UWF retinal mosaic · FOV: 200 degrees.
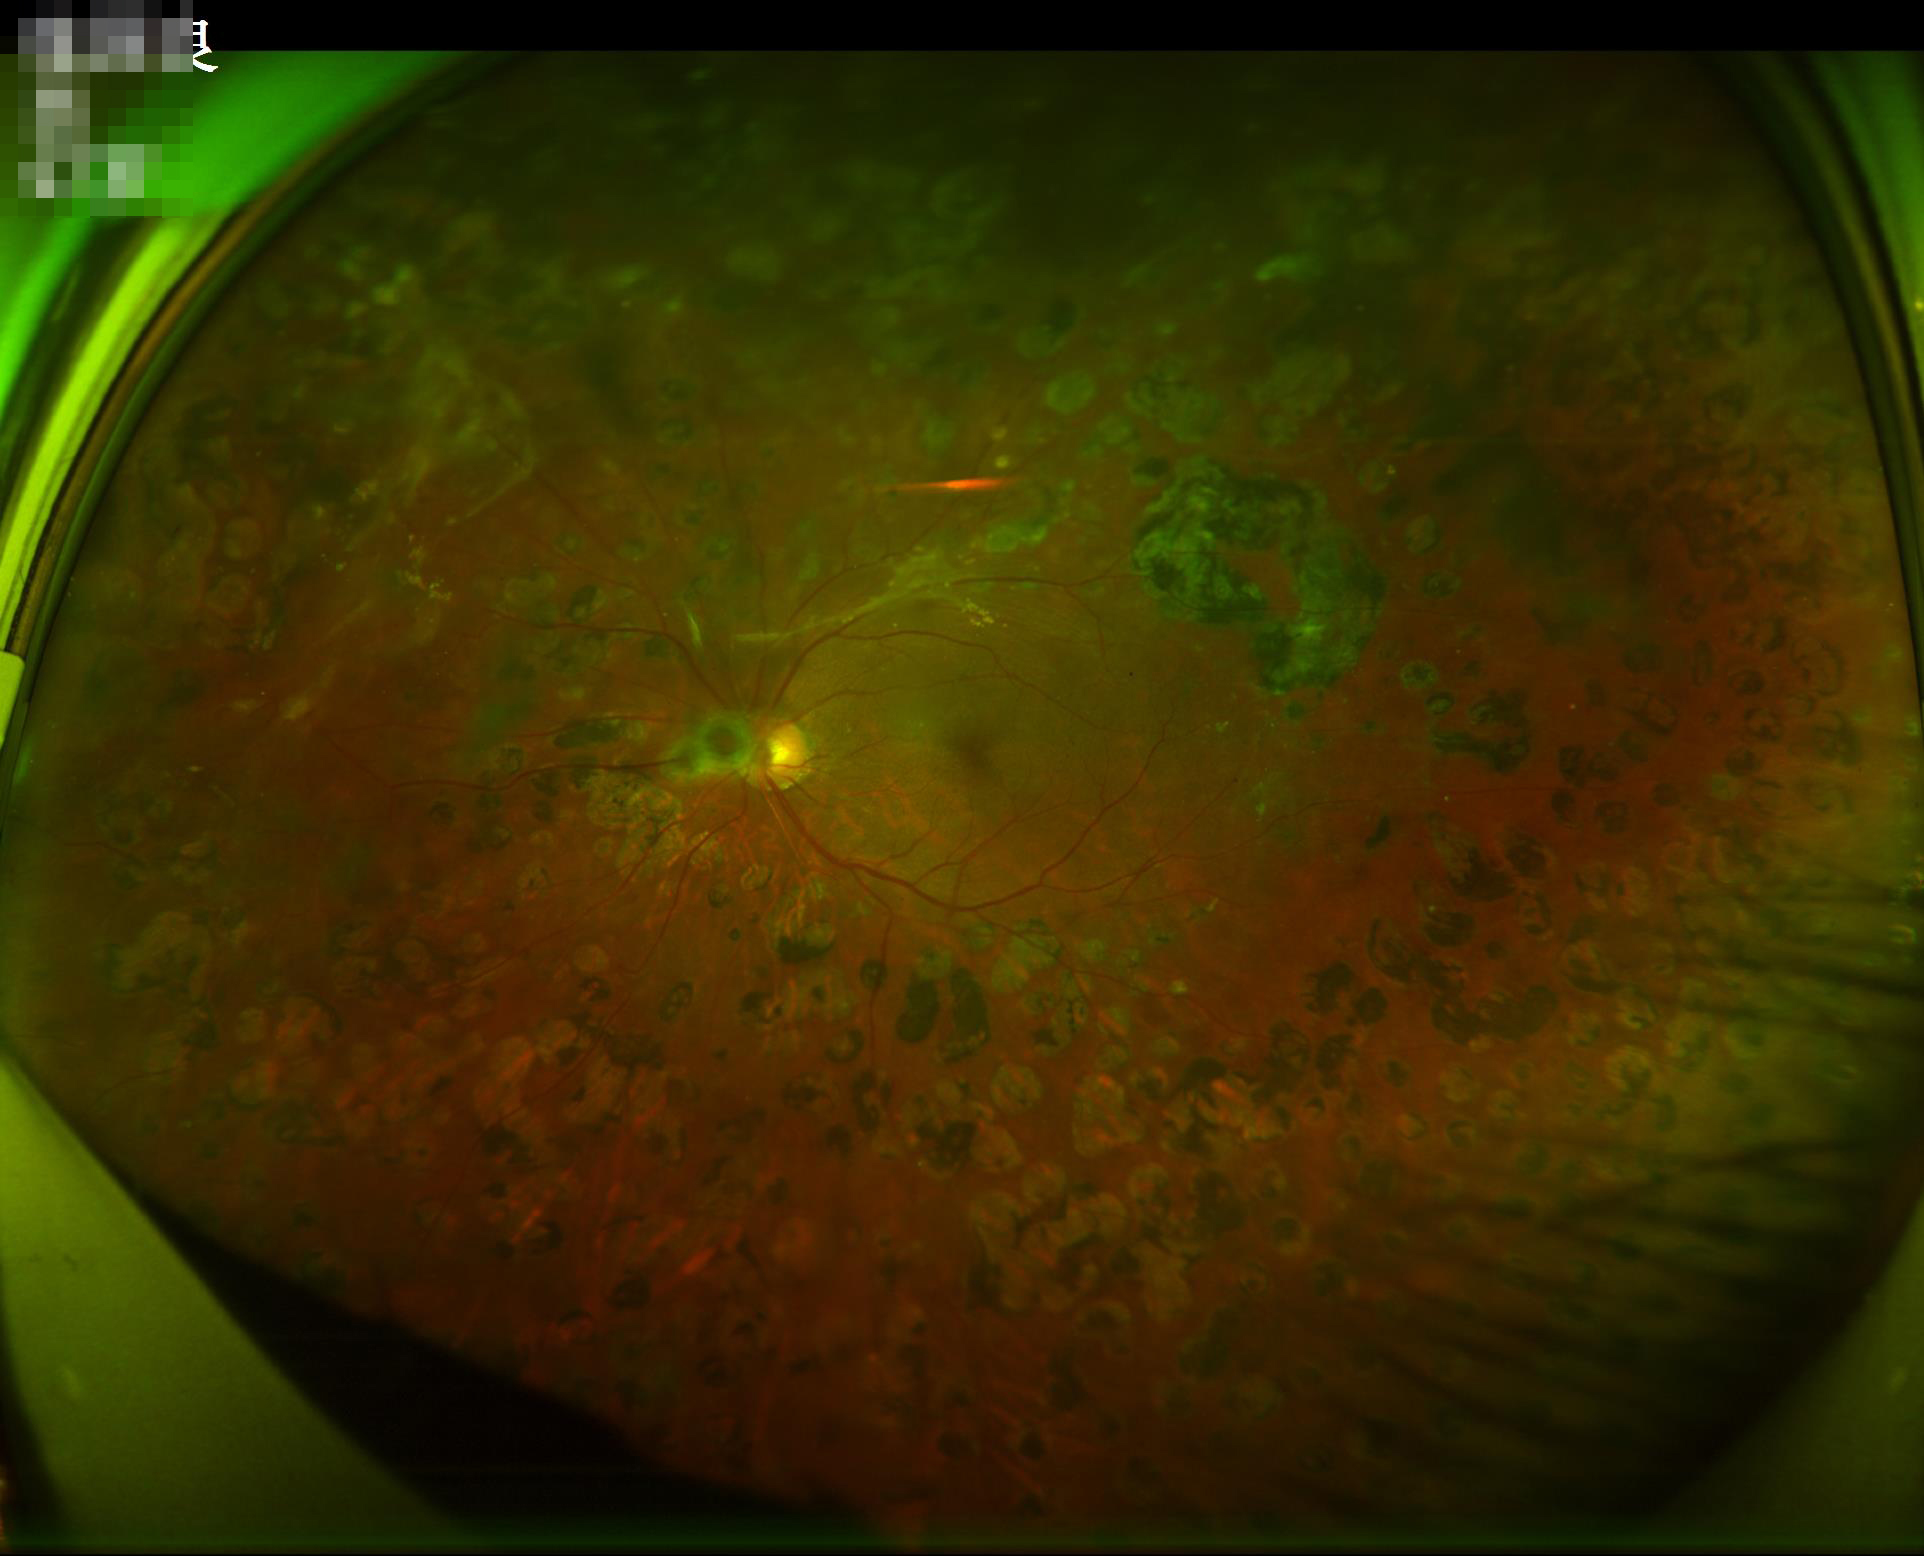 Image quality assessment: overall: good and suitable for diagnostic use | sharpness: optic disc, vessels, and background in focus | illumination/color: good illumination and color balance.